Handheld portable fundus camera image; 60-degree field of view:
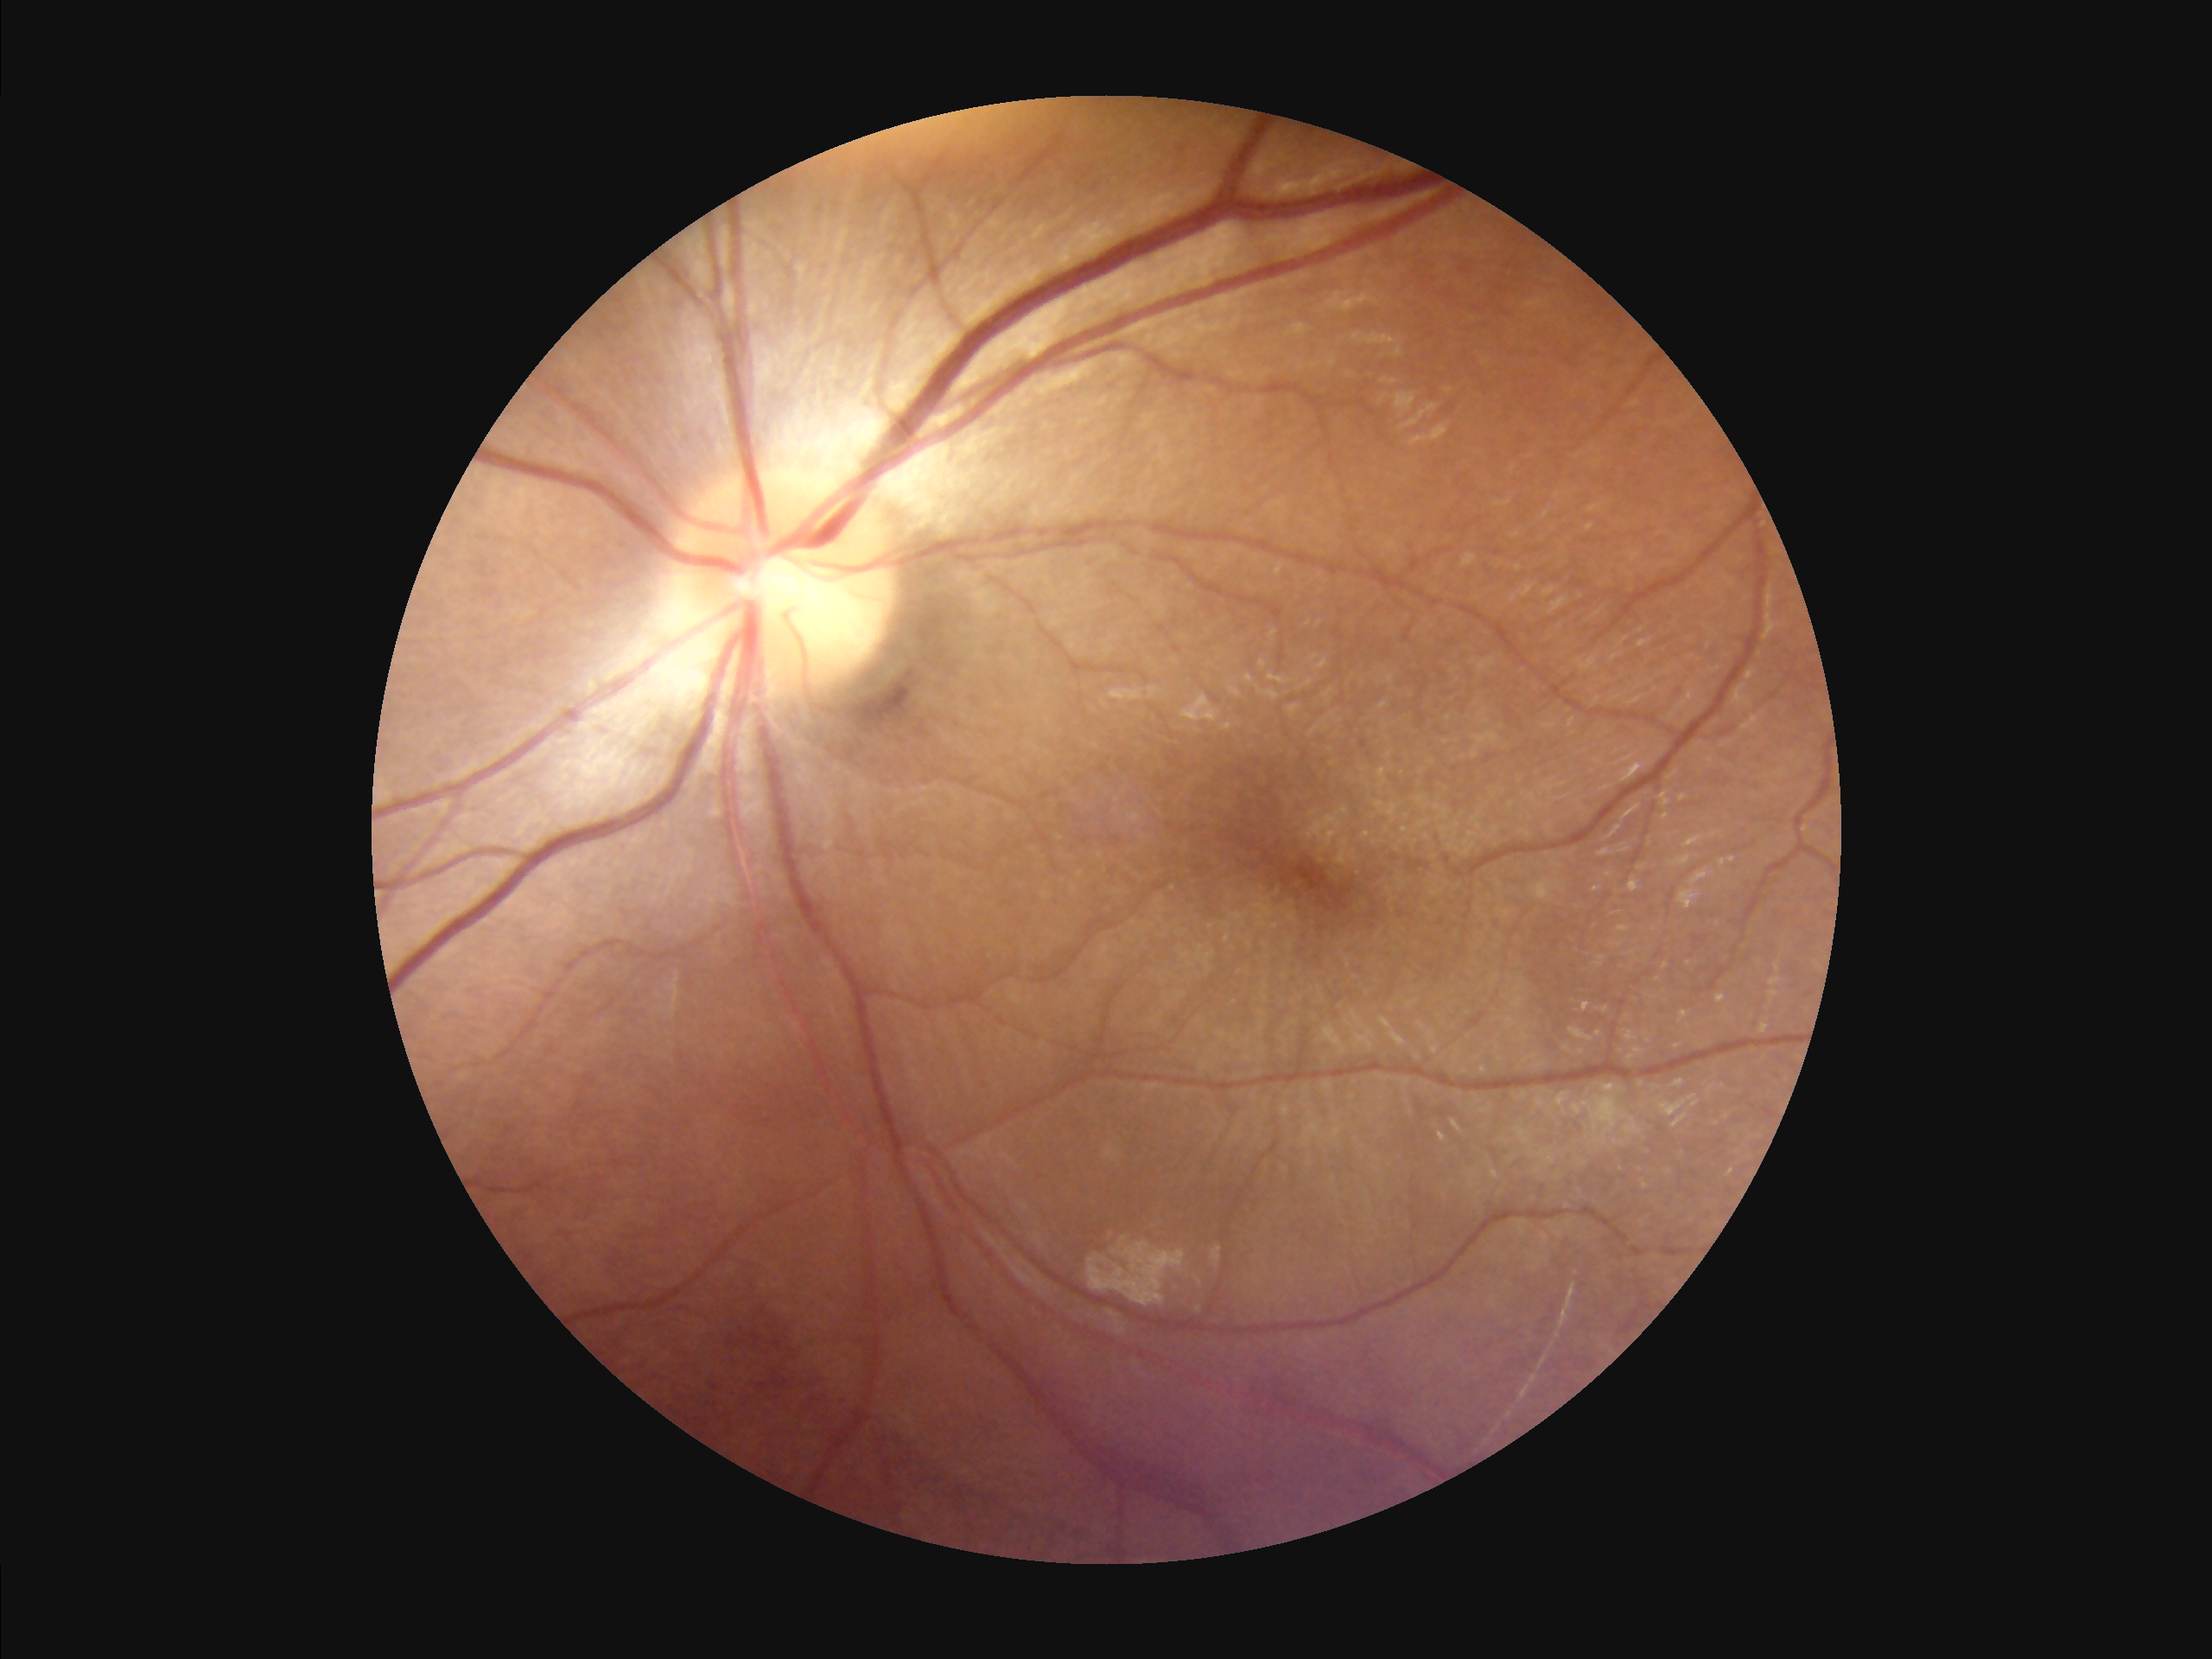 Vessels and details are readily distinguishable.
Image is sharp throughout the field.
Overall quality is good and the image is gradable.
Illumination is even.